Acquired with a NIDEK AFC-230, posterior pole color fundus photograph, 45° field of view: 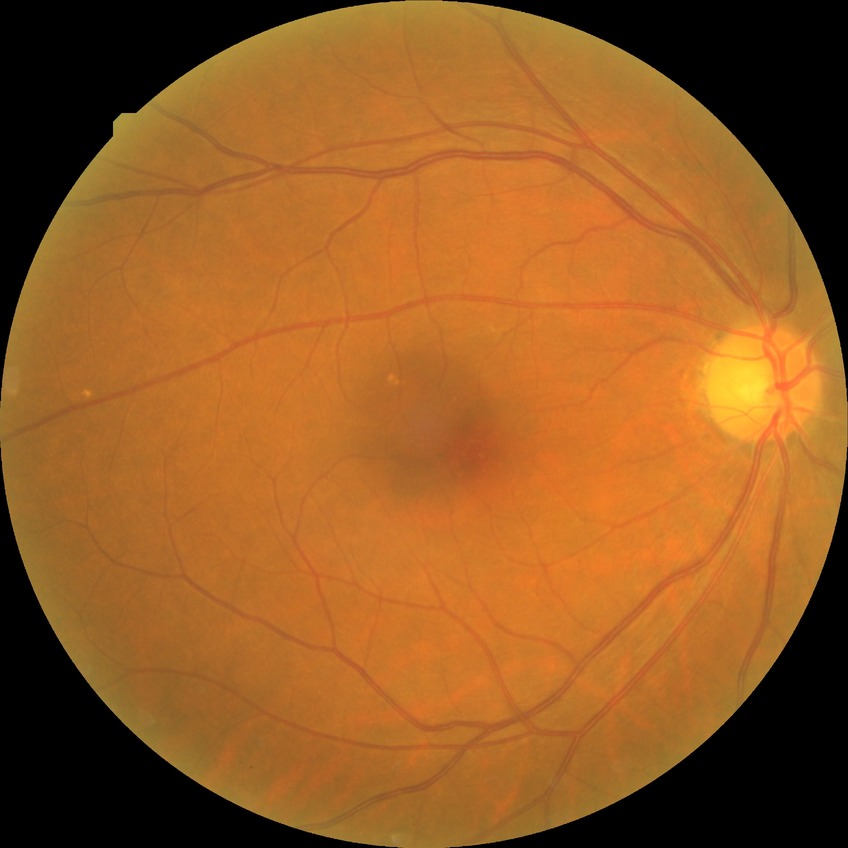 Diabetic retinopathy severity is no diabetic retinopathy.